2184x1690px, 45° FOV: 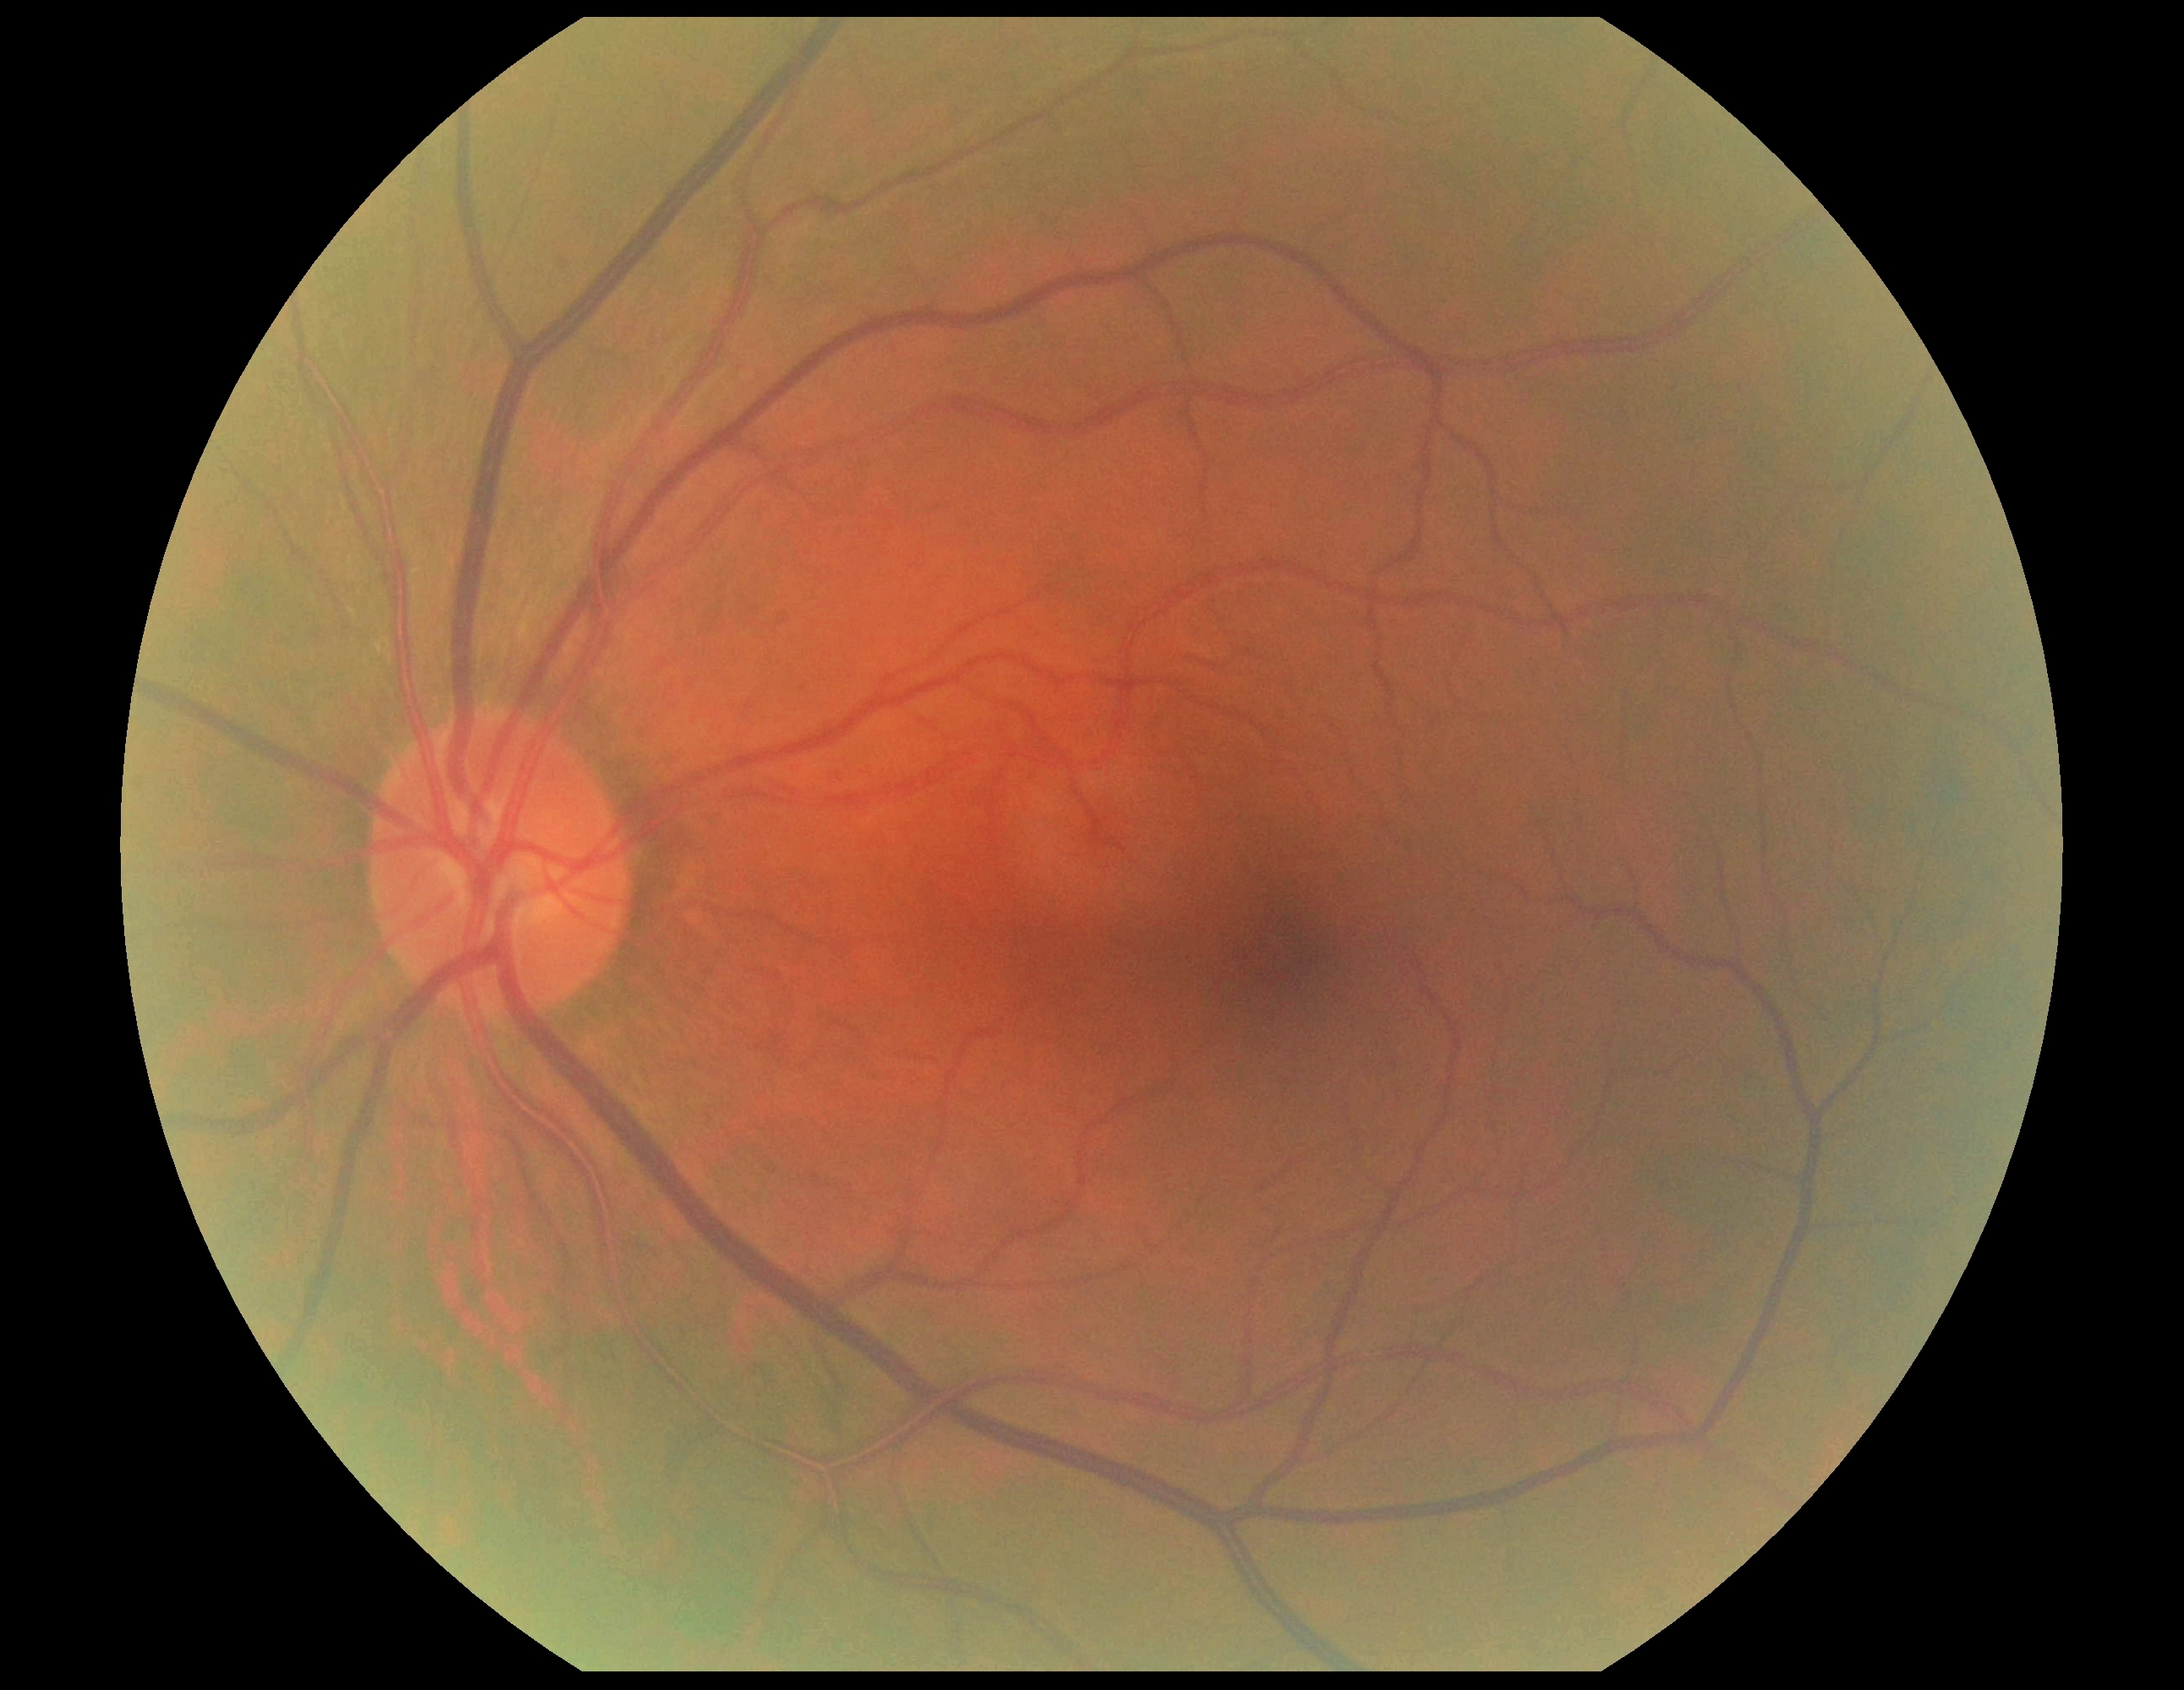
Diabetic retinopathy severity: grade 0 (no apparent retinopathy).